Diabetic retinopathy graded by the modified Davis classification
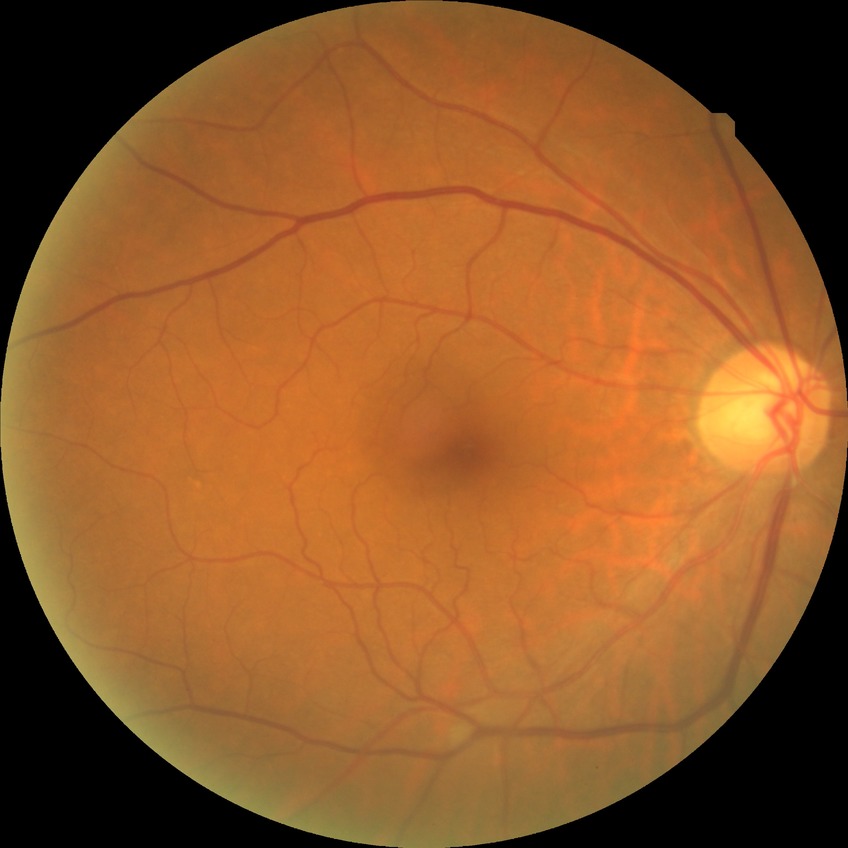 DR: NDR